NIDEK AFC-230 fundus camera:
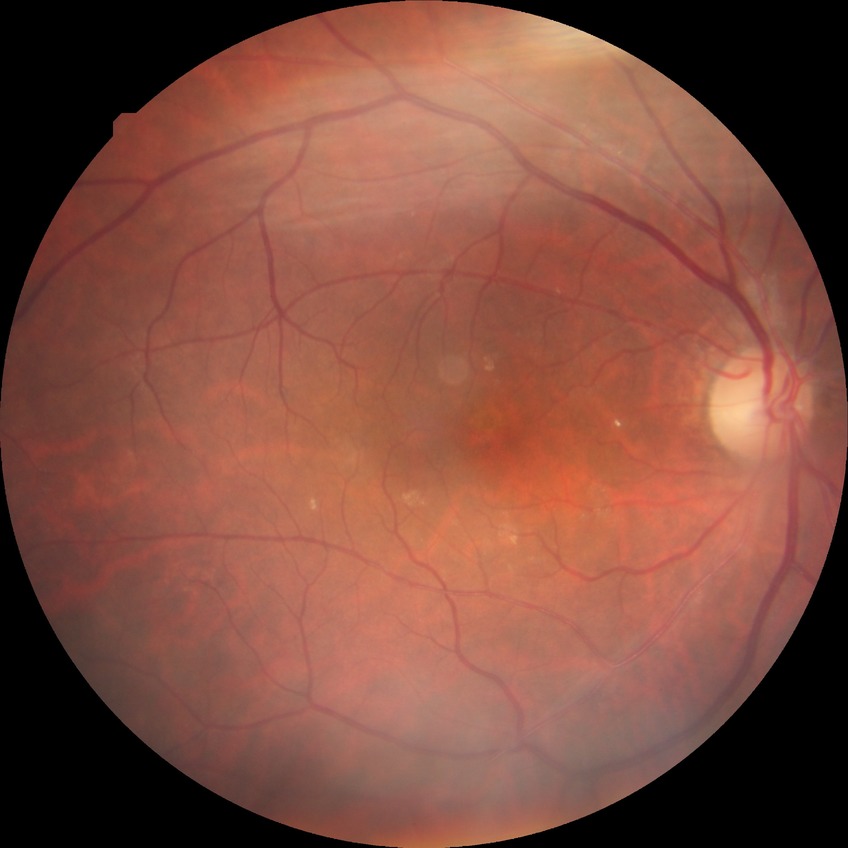

Assessment:
– diabetic retinopathy (DR) — no diabetic retinopathy (NDR)